CFP:
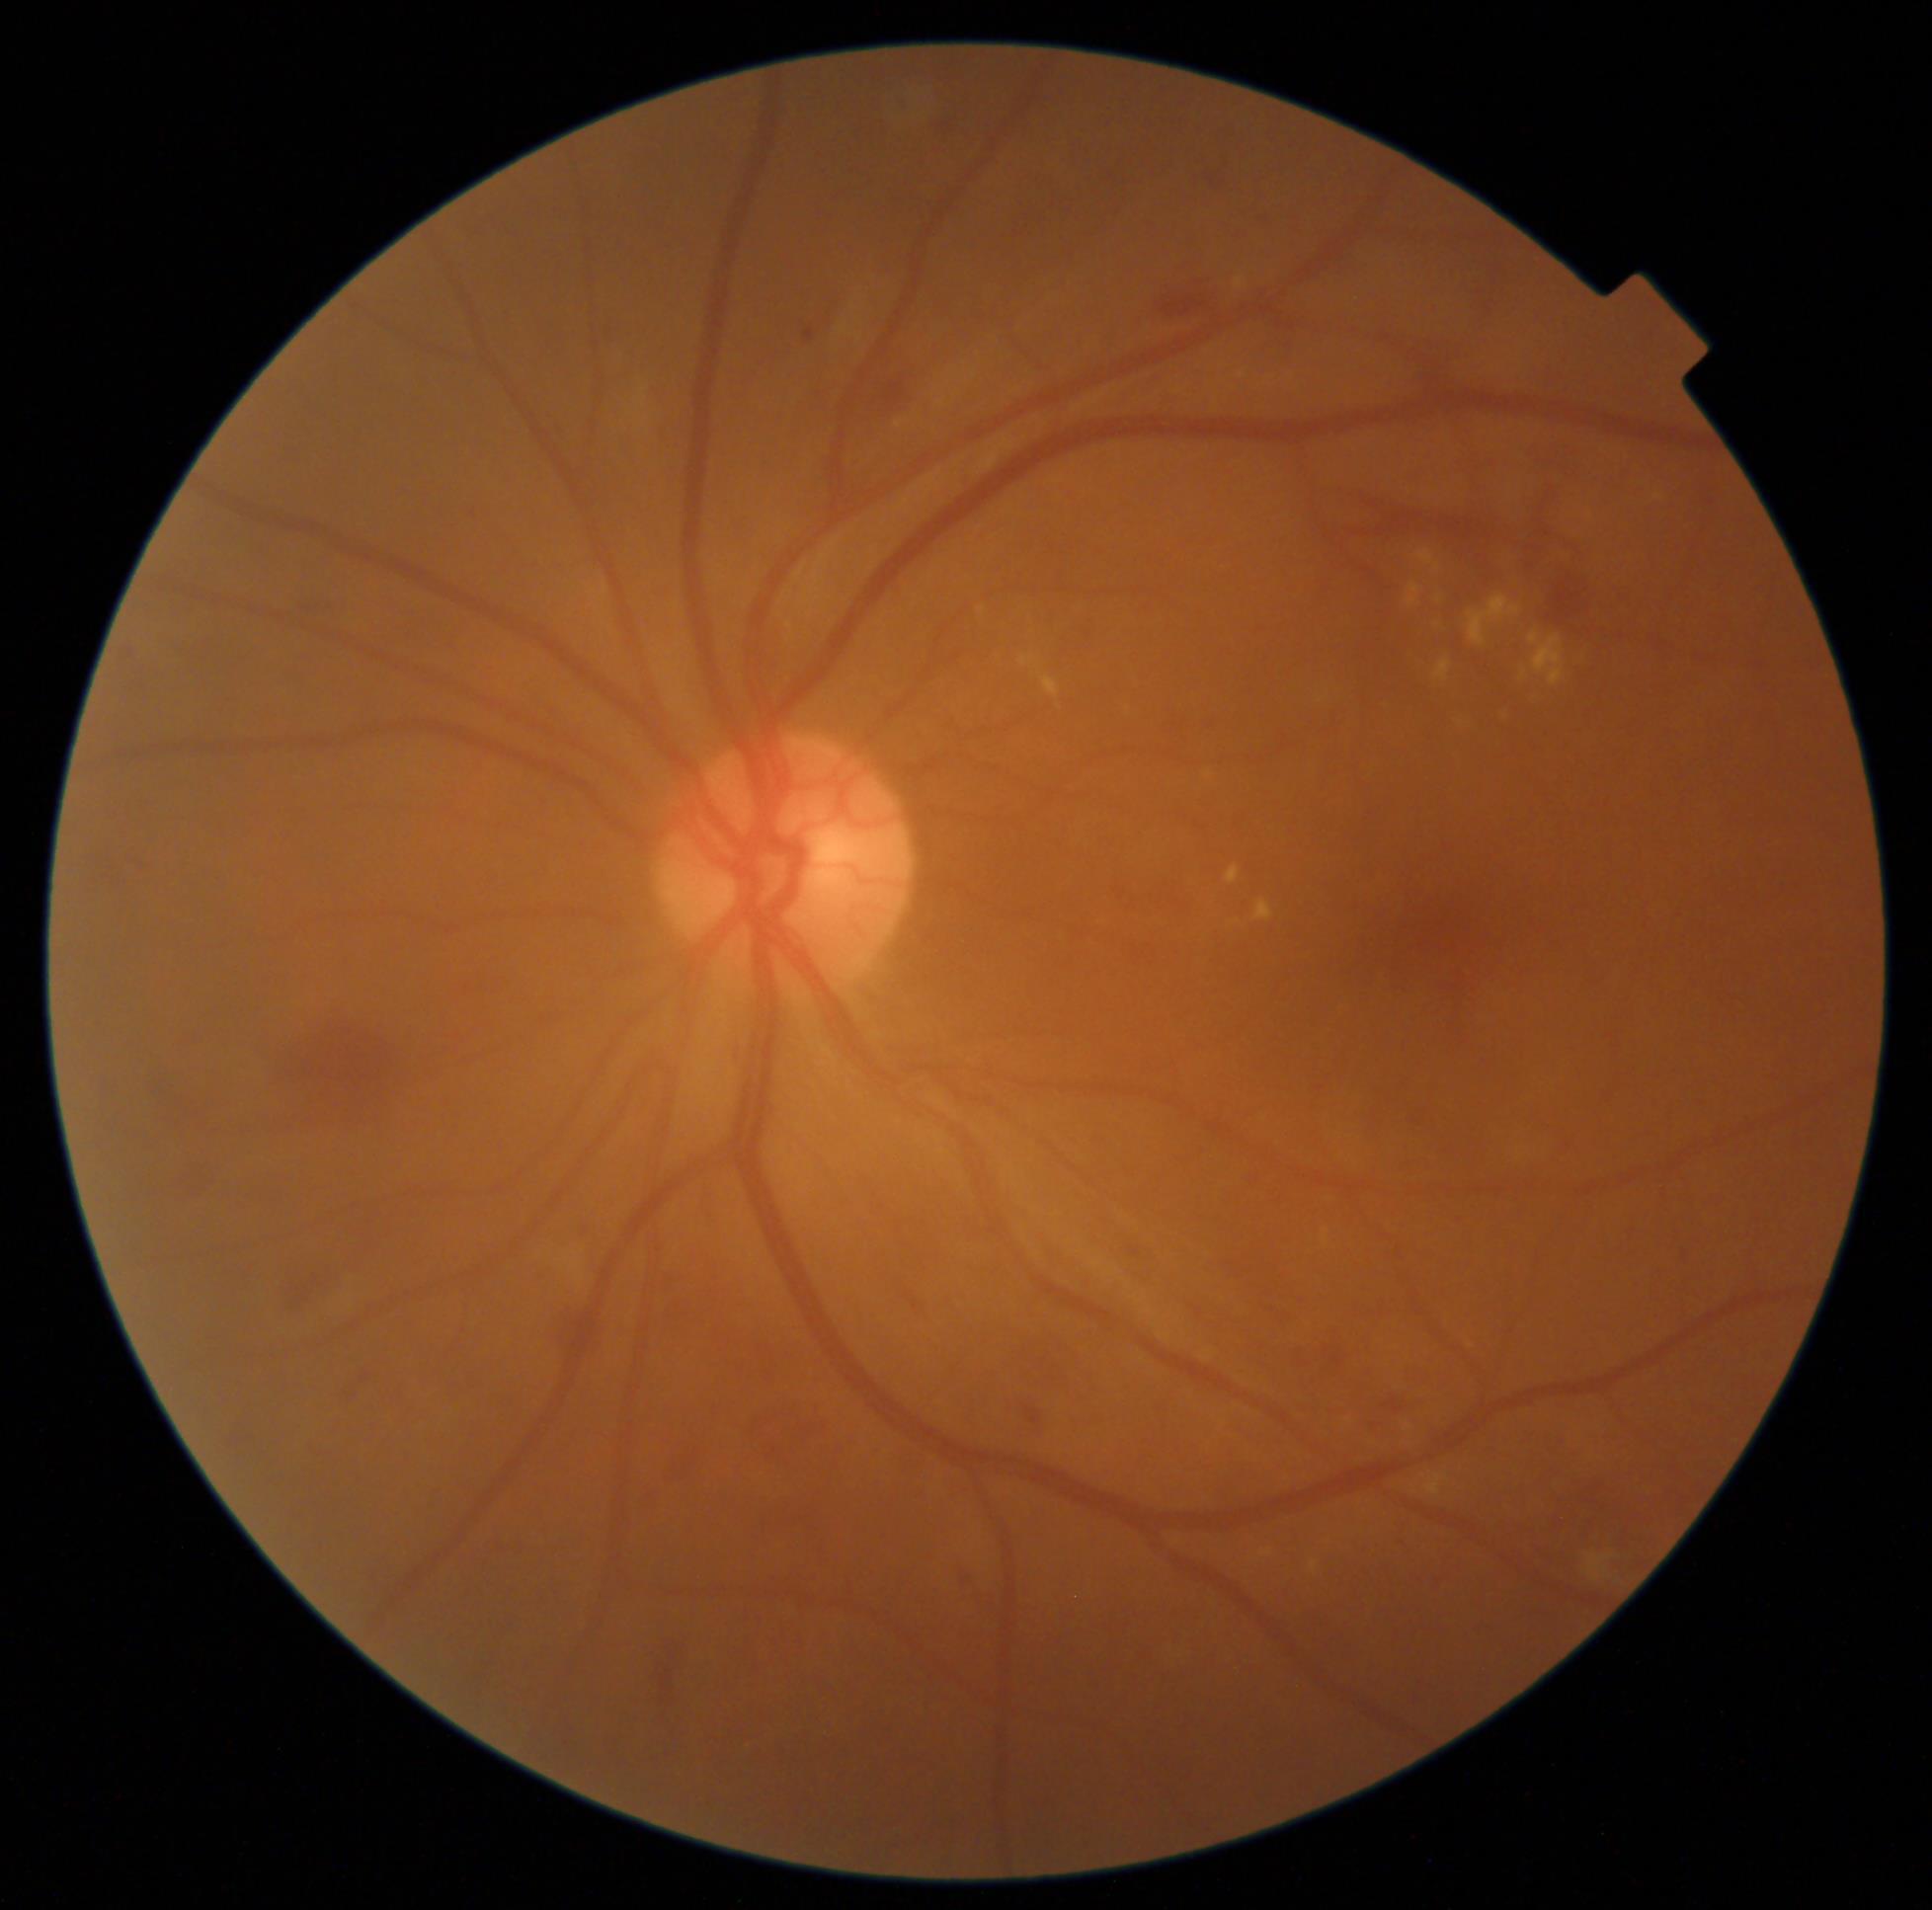 DR grade: moderate non-proliferative diabetic retinopathy (2).